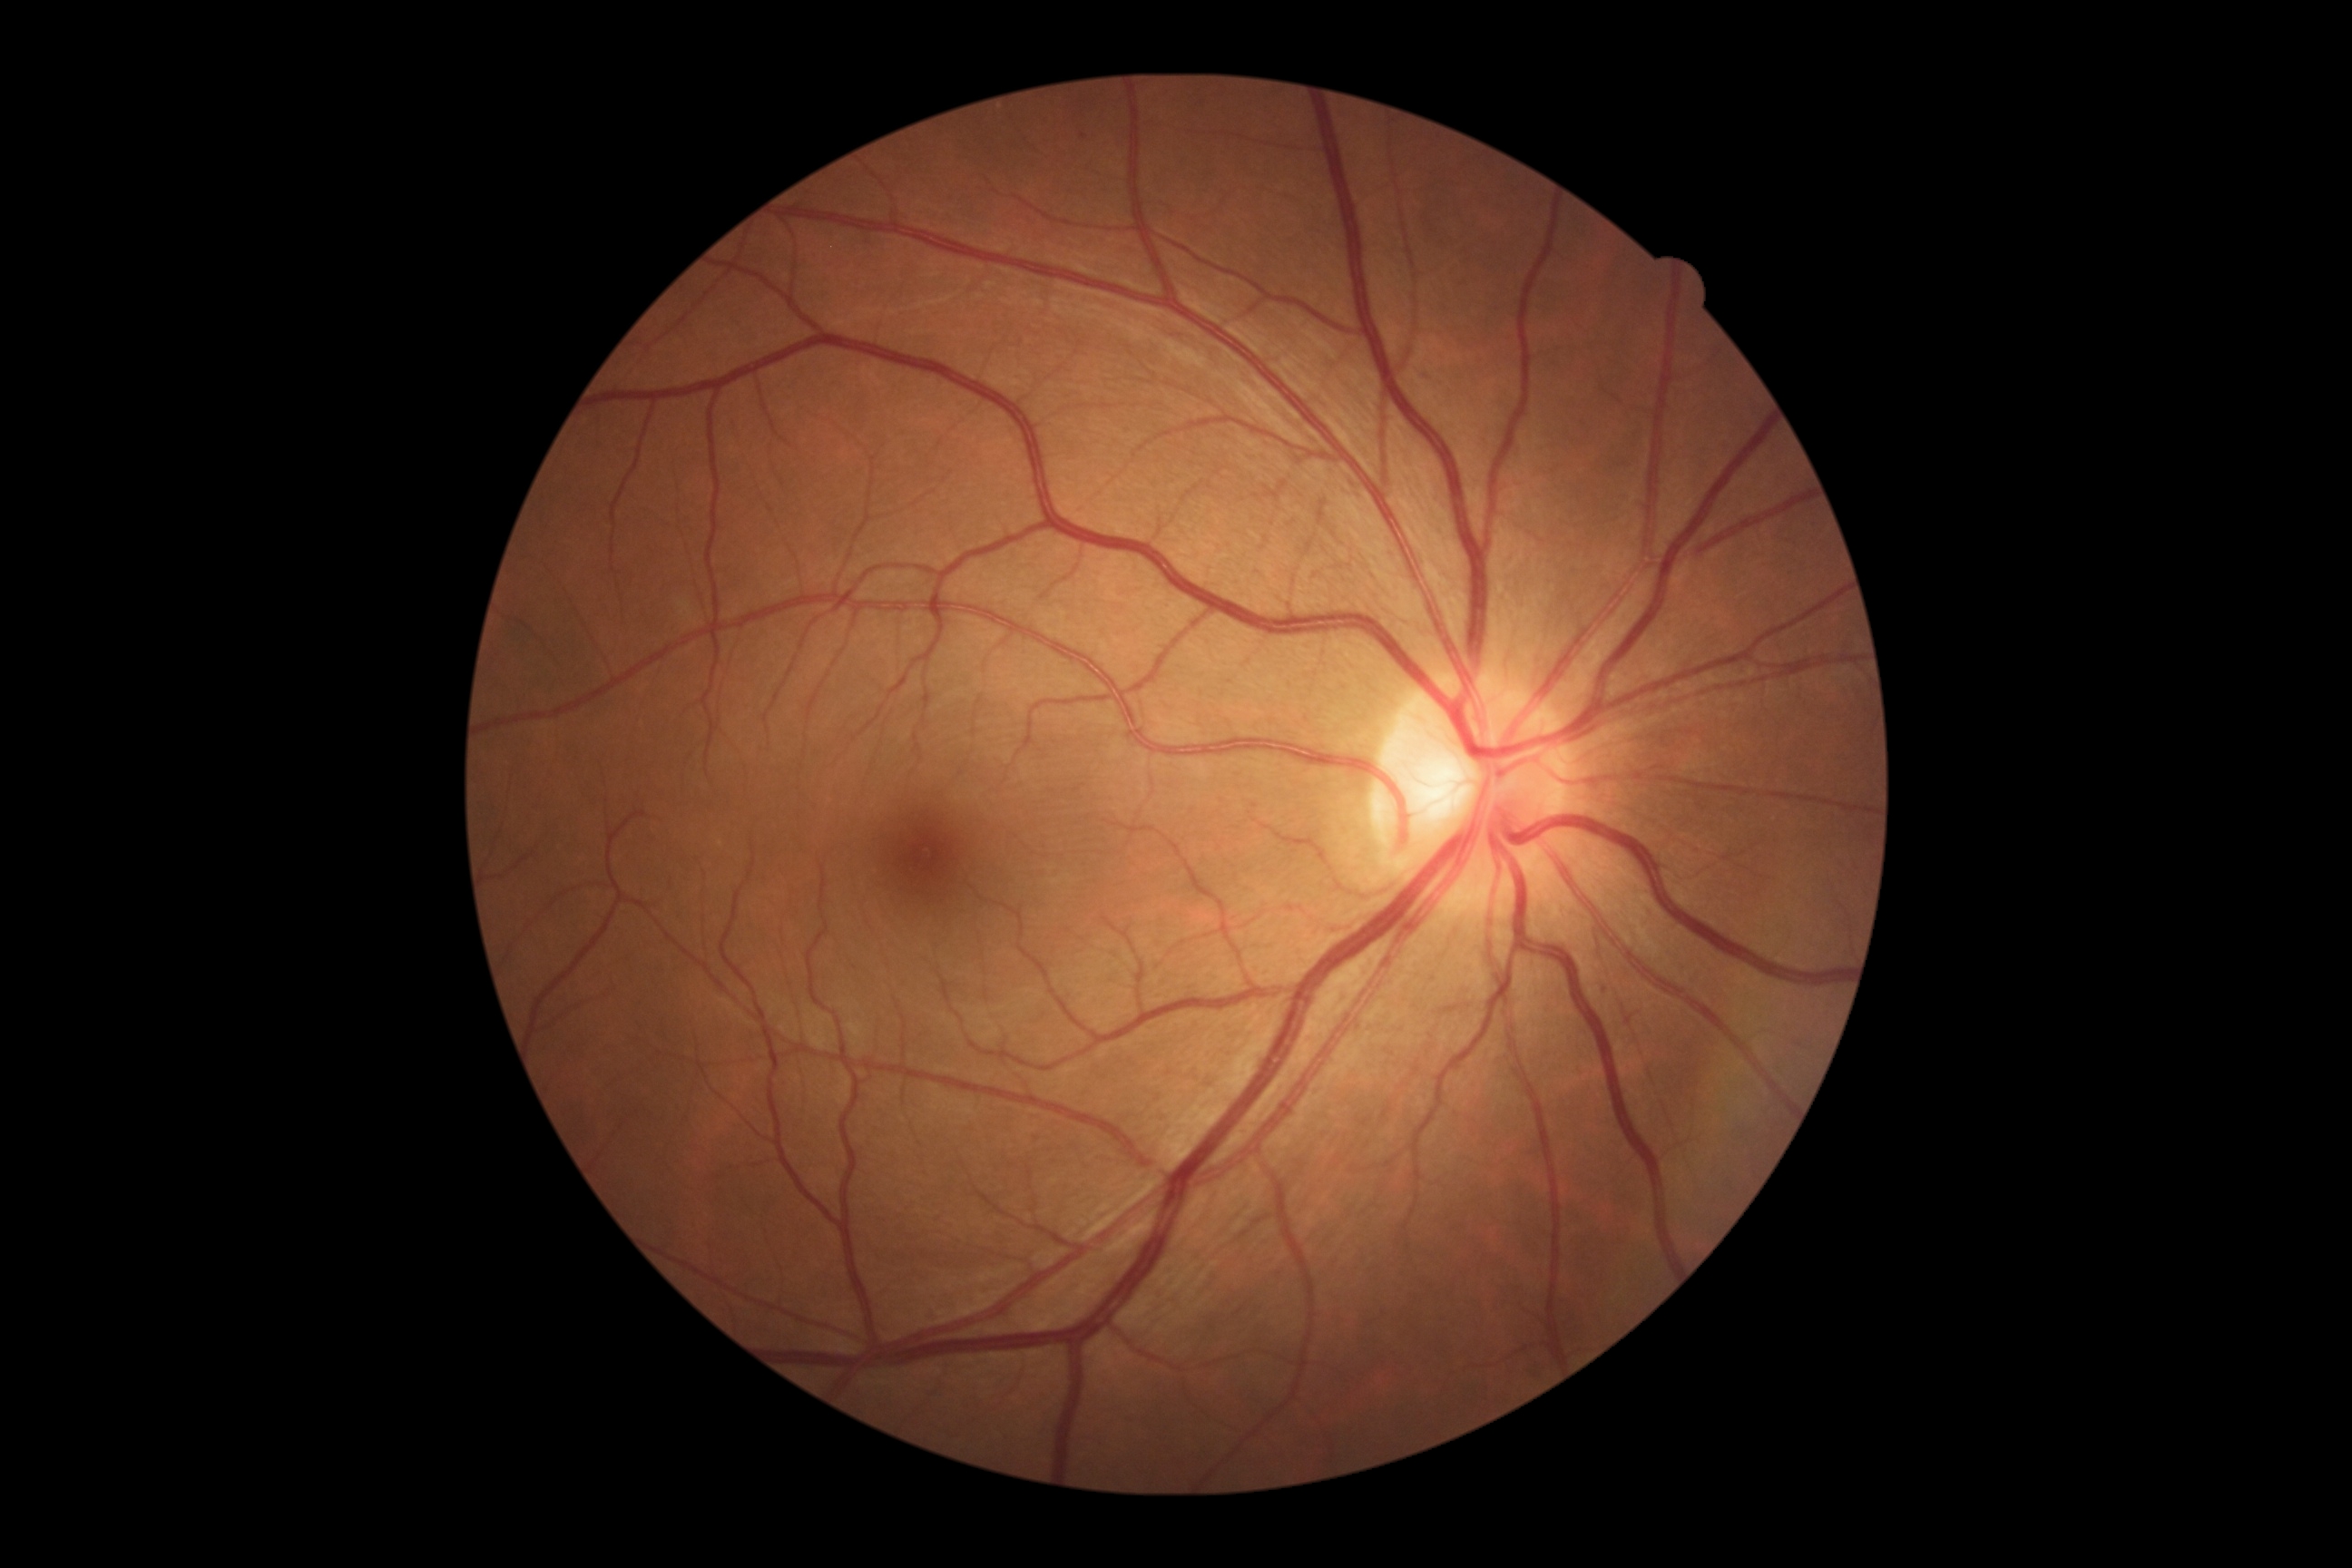
dr_grade: grade 1 — presence of microaneurysms only
dr_category: non-proliferative diabetic retinopathy